Retinal fundus photograph. 512x512
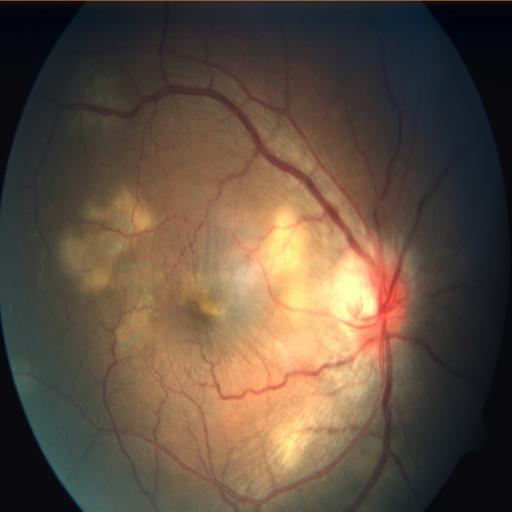
Impression: choroidal folds (CF) | chorioretinitis (CRS) | optic disc edema (ODE).